Captured on a Nidek AFC-330 fundus camera · cropped to the optic nerve head · non-mydriatic.
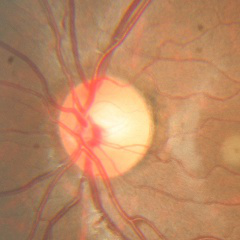 No evidence of glaucoma.